Infant wide-field fundus photograph: 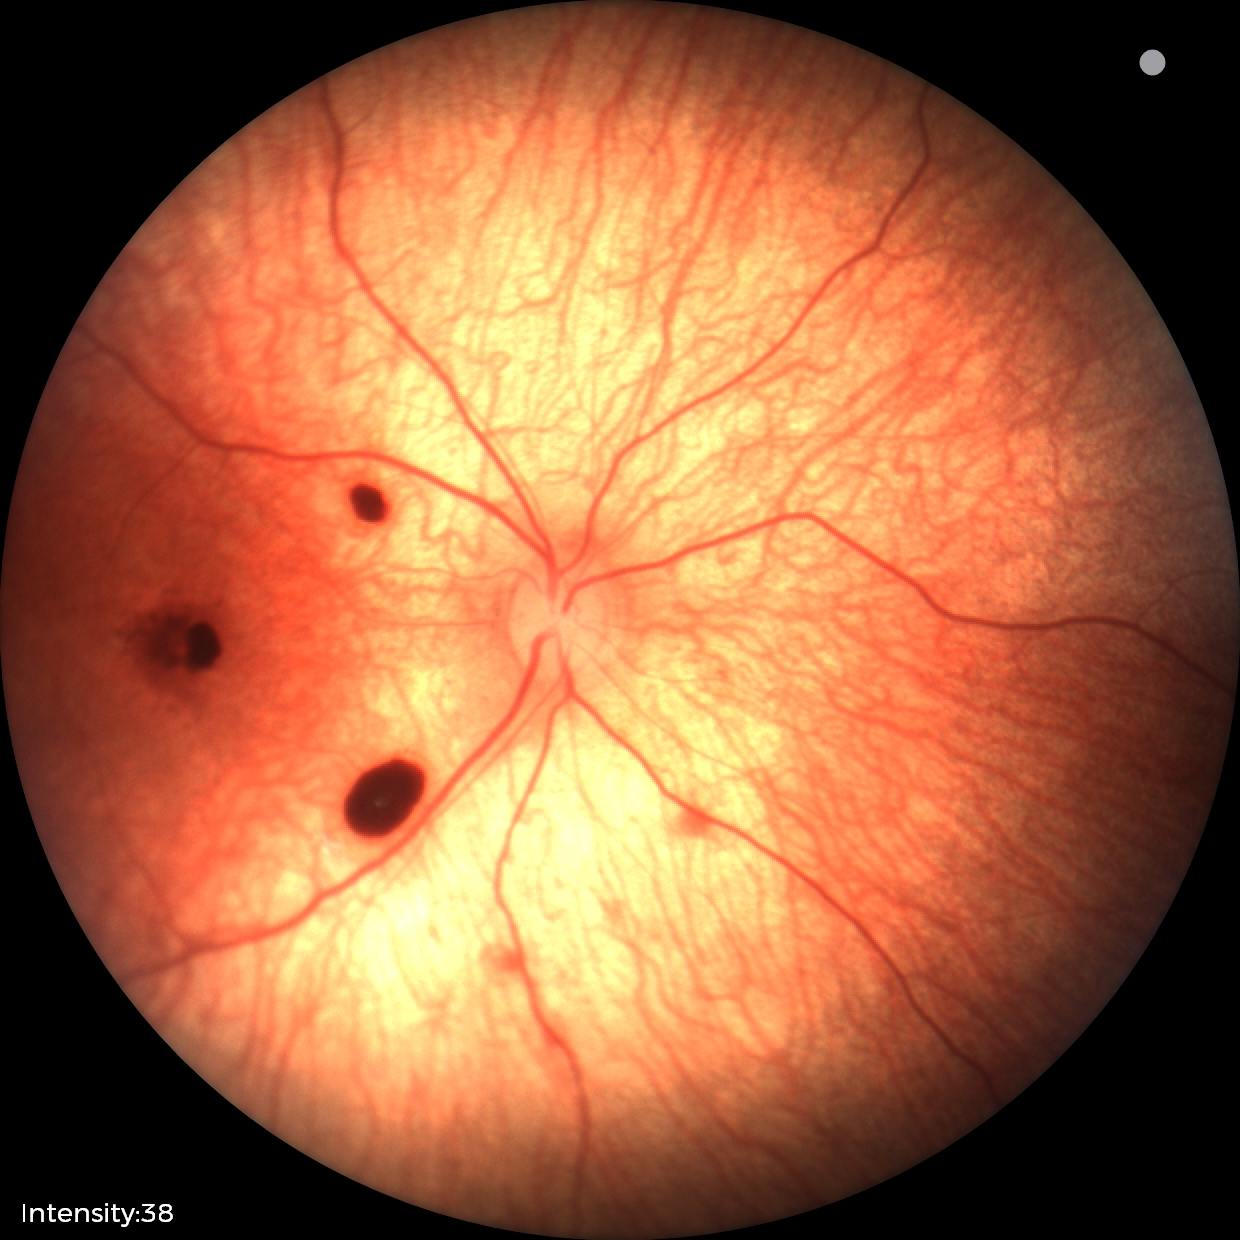

Diagnosis from this screening exam: retinal hemorrhages.